2352x1568: 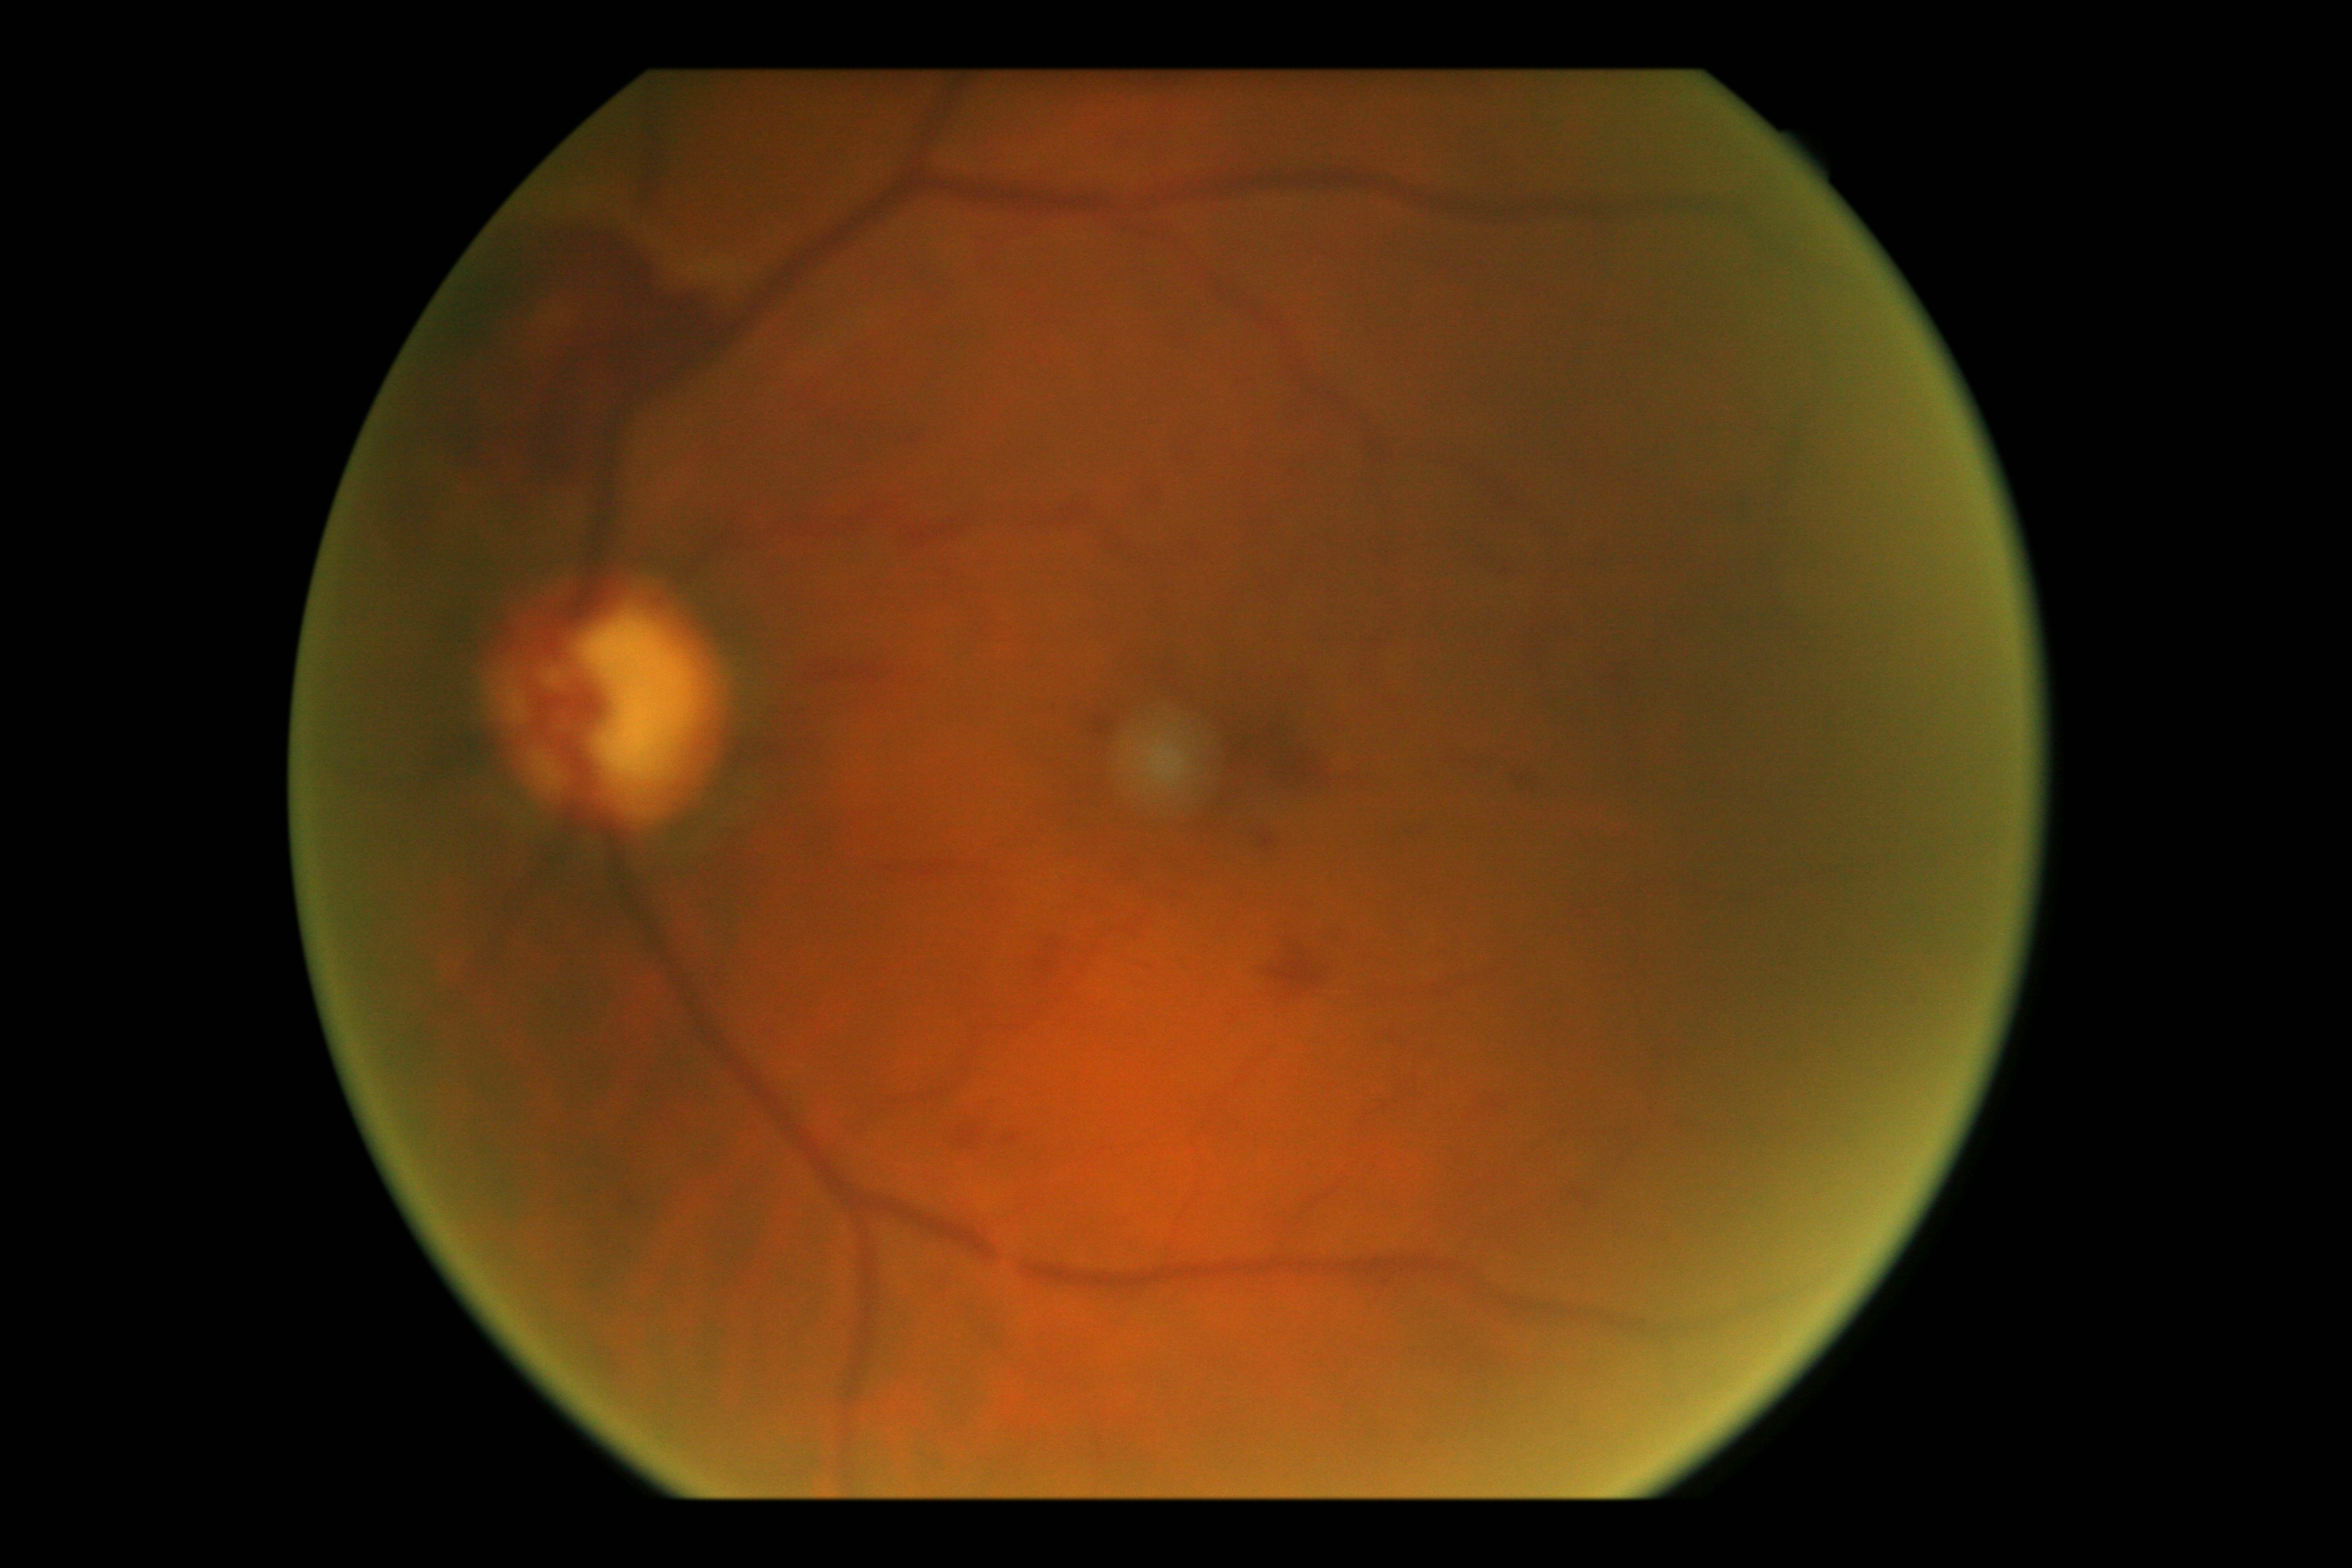
dr_category: proliferative diabetic retinopathy
dr_grade: 4/4